737 x 725 pixels. 45° FOV
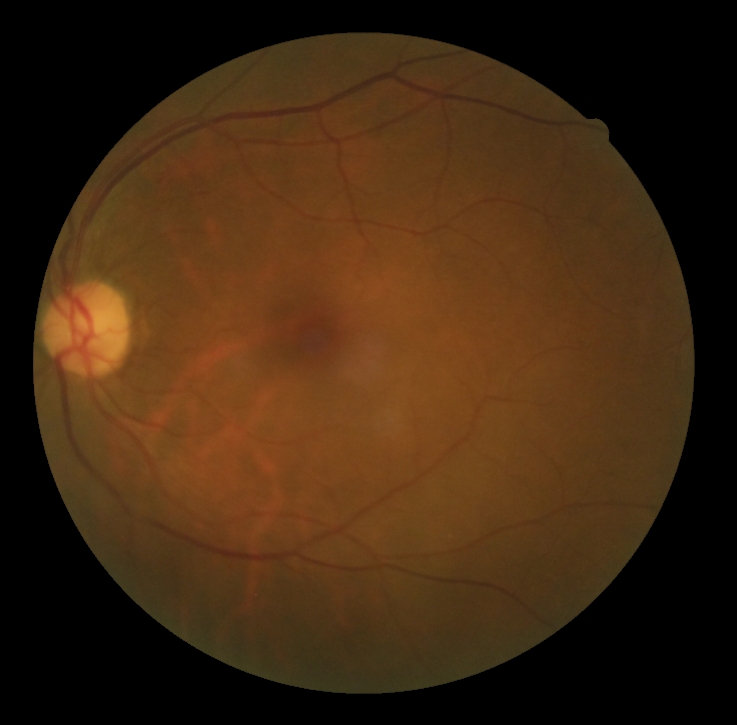

• DR grade: 0 (no apparent retinopathy)